45° FOV; color fundus photograph.
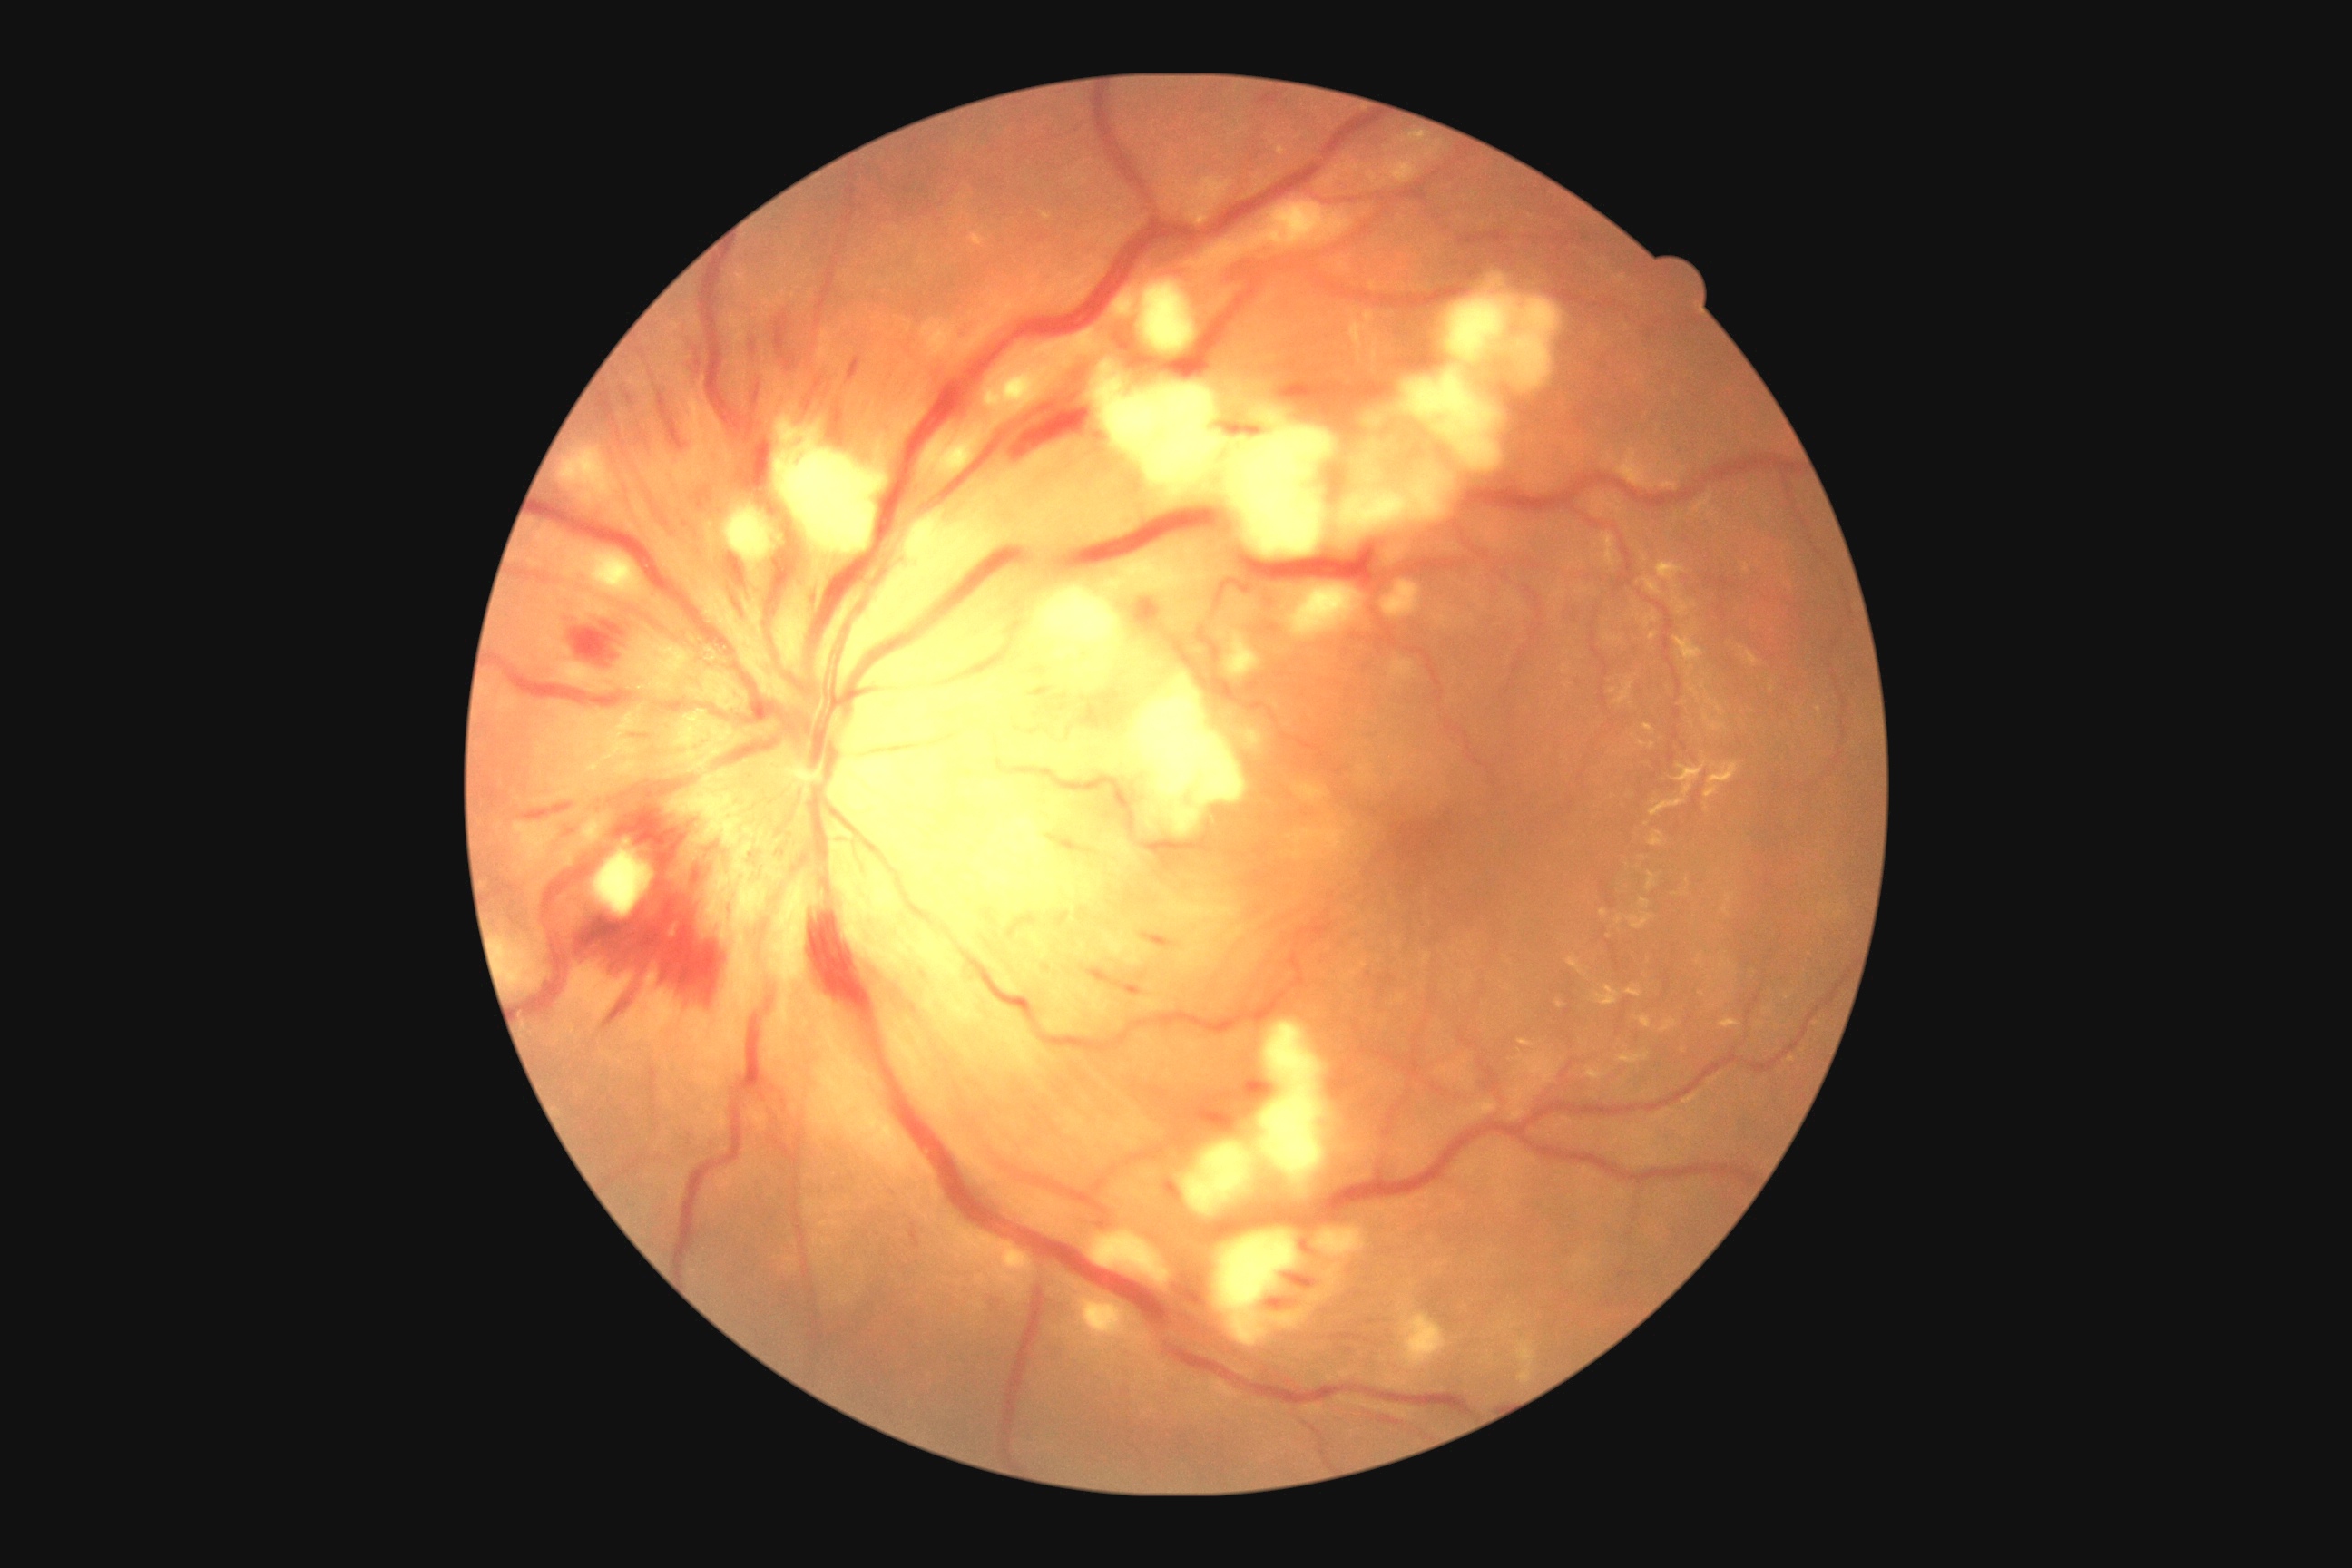
Diabetic retinopathy: 2/4.